Phoenix ICON, 100° FOV; Phoenix ICON wide-field infant fundus image.
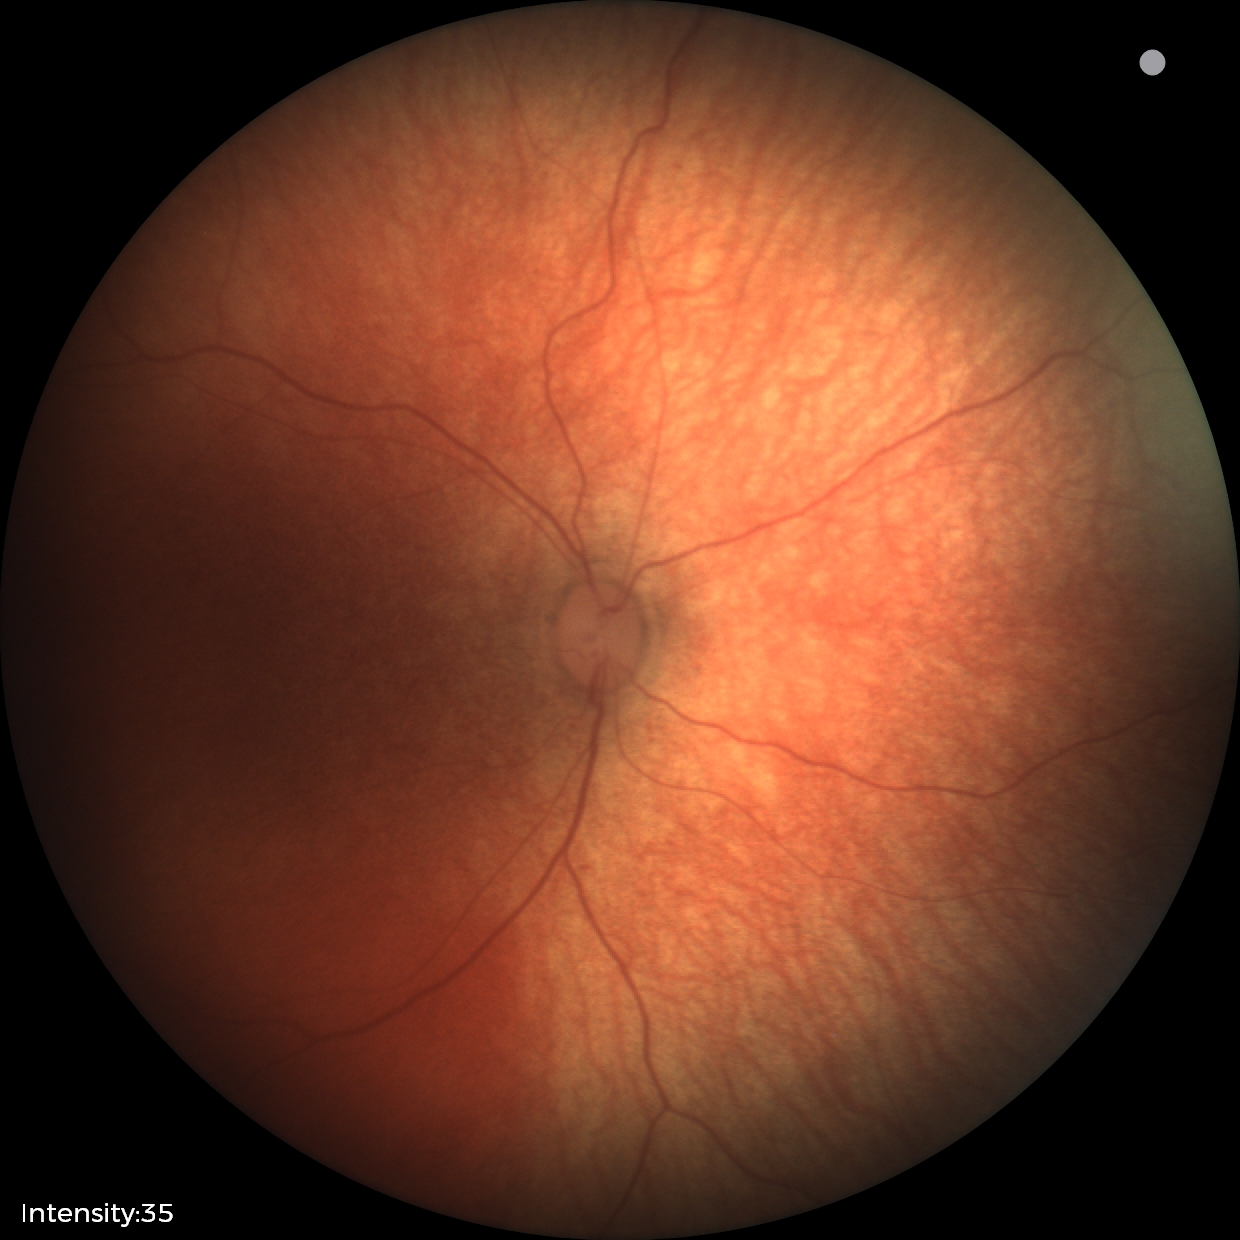
Screening examination diagnosed as physiological.